Nonmydriatic fundus photograph.
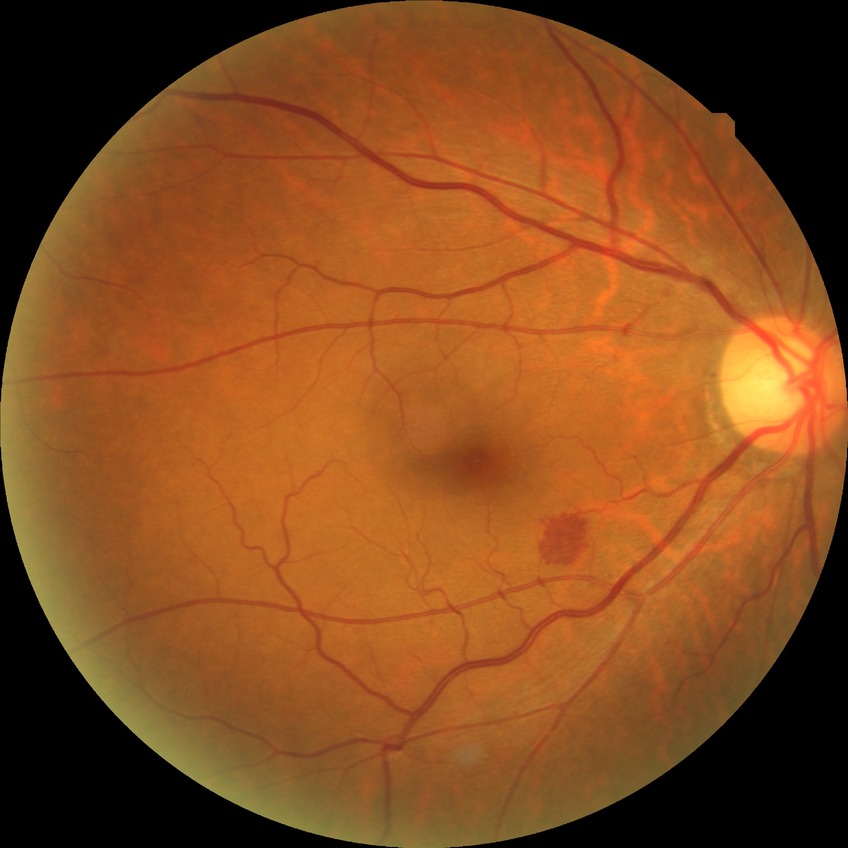

DR: NDR. No diabetic retinal disease findings.